Captured with the Natus RetCam Envision (130° field of view) · pediatric retinal photograph (wide-field) · 1440x1080px:
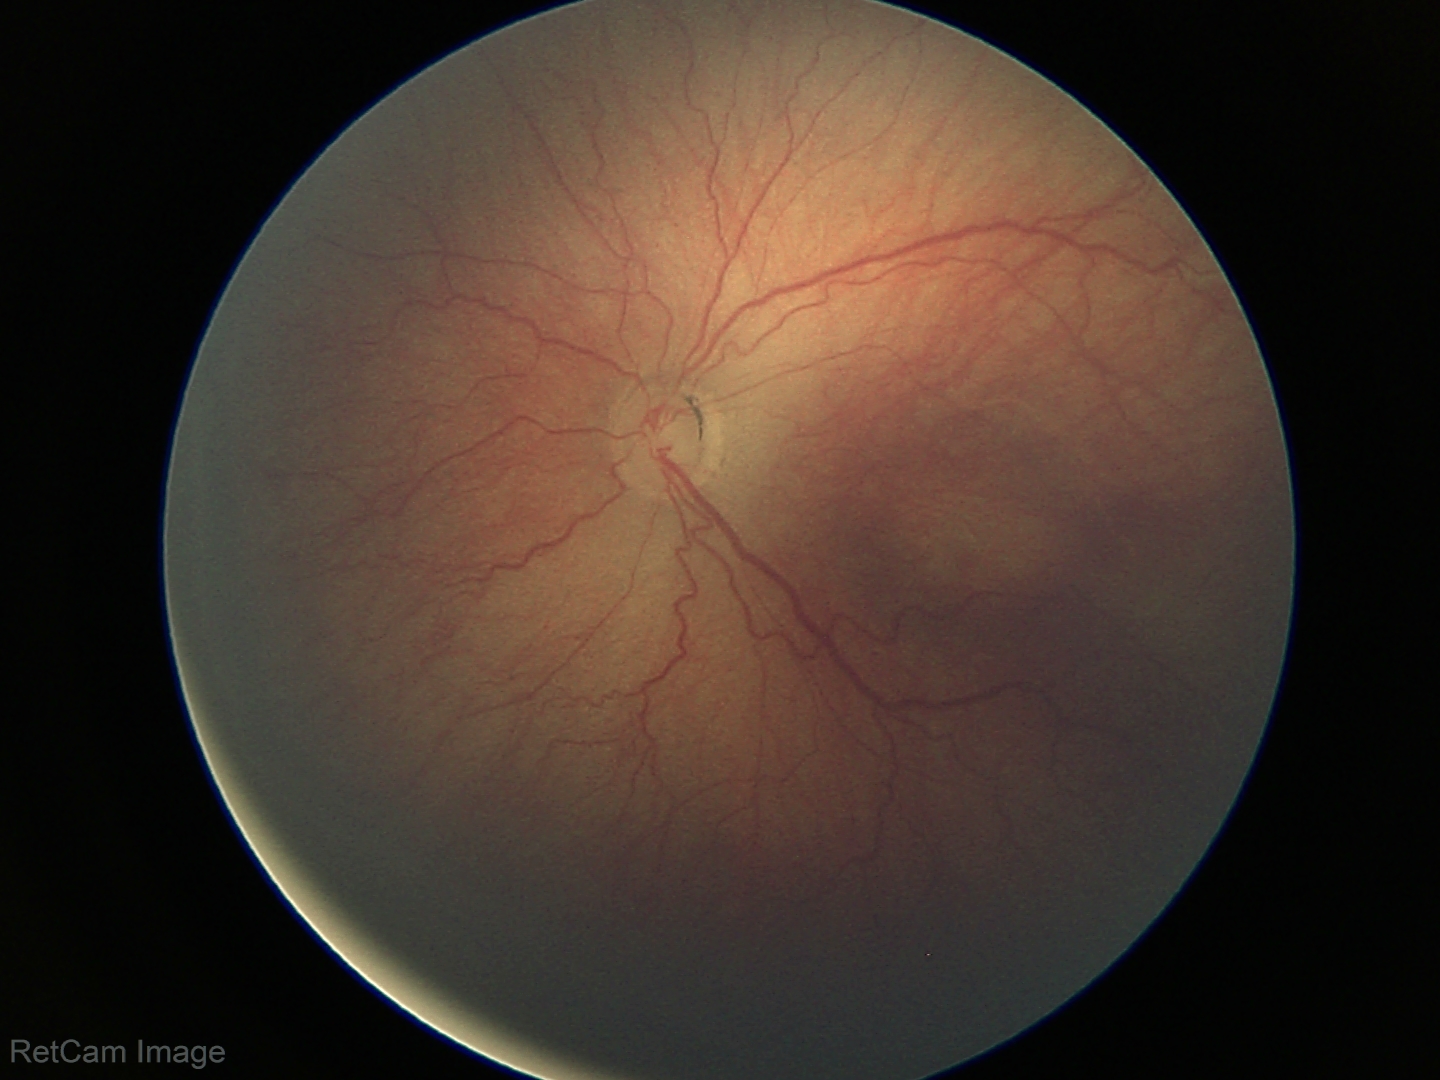 Screening diagnosis: no plus disease | retinopathy of prematurity (ROP) stage 3.